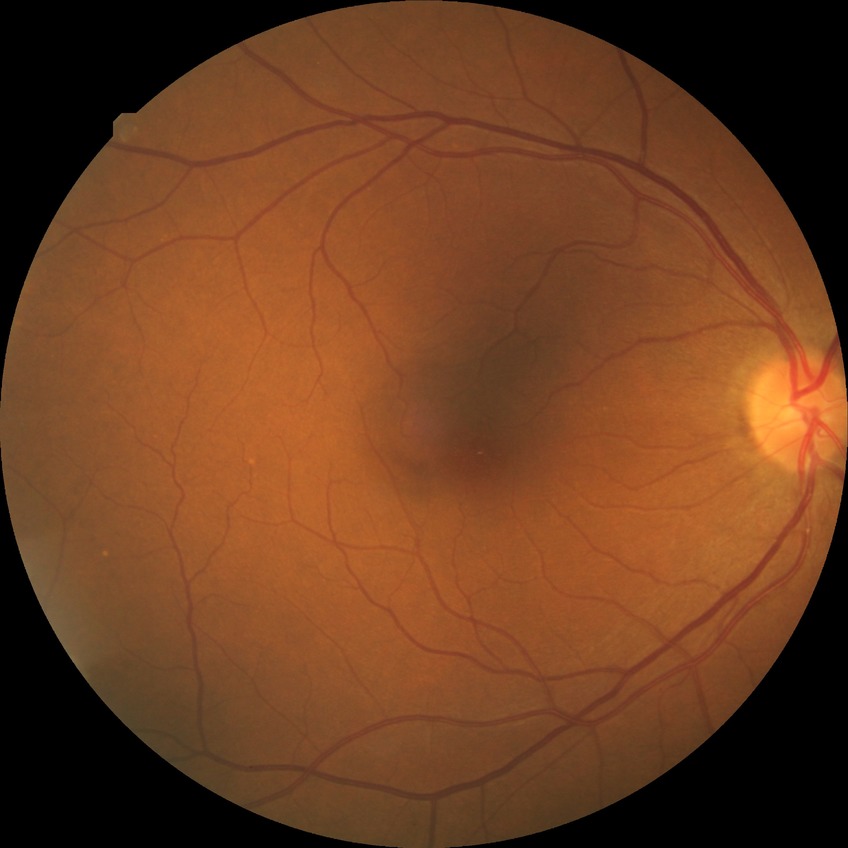
DR impression = no DR findings; DR stage = NDR.